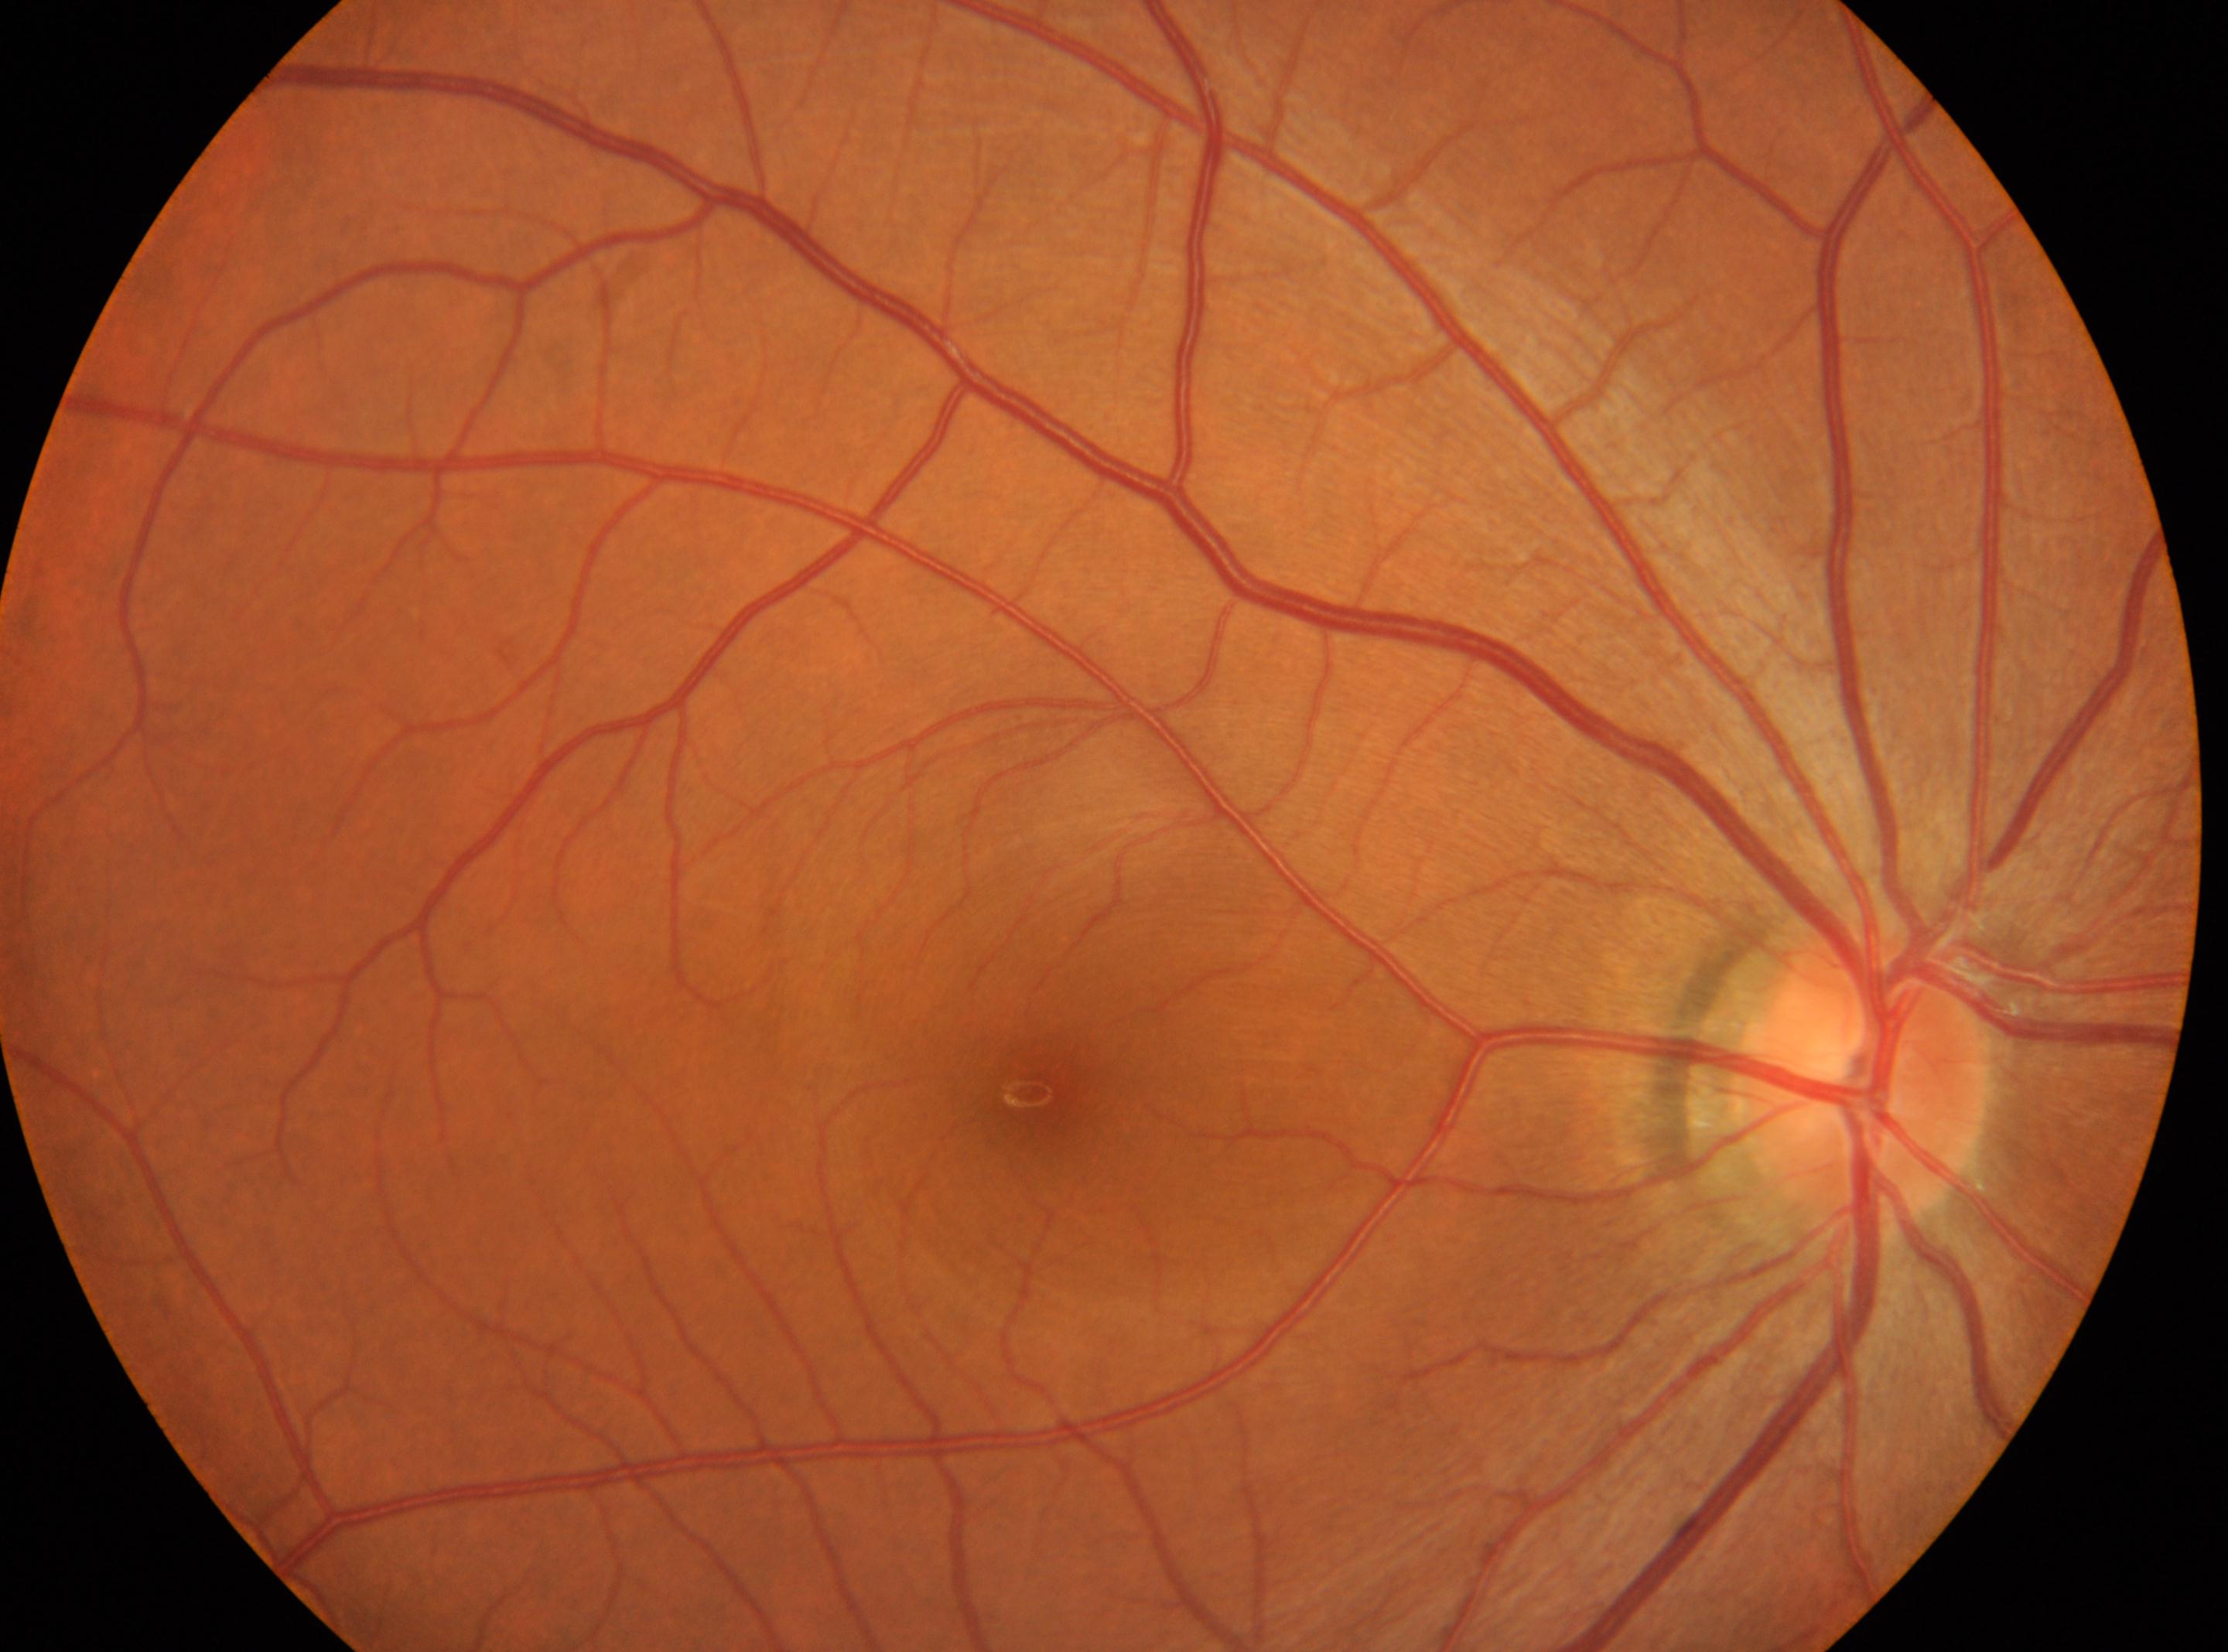
Optic disk located at 1861, 1074. Fovea: 1038, 1089. Diabetic retinopathy severity is grade 0 (no apparent retinopathy). This is the right eye.